848x848
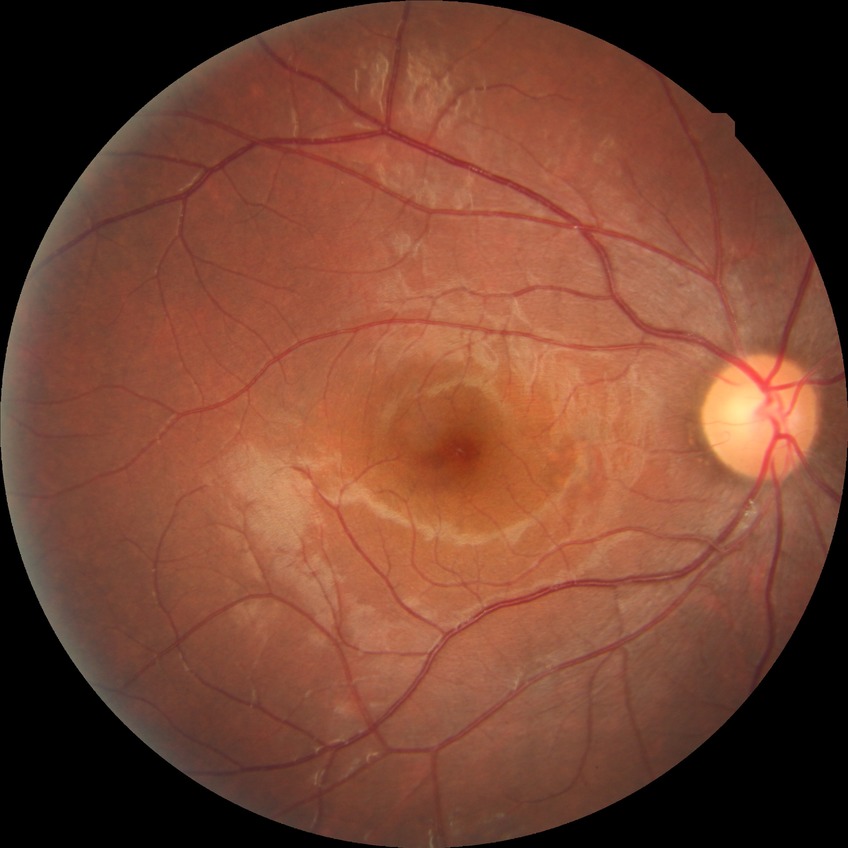 DR stage@NDR.